Modified Davis classification — 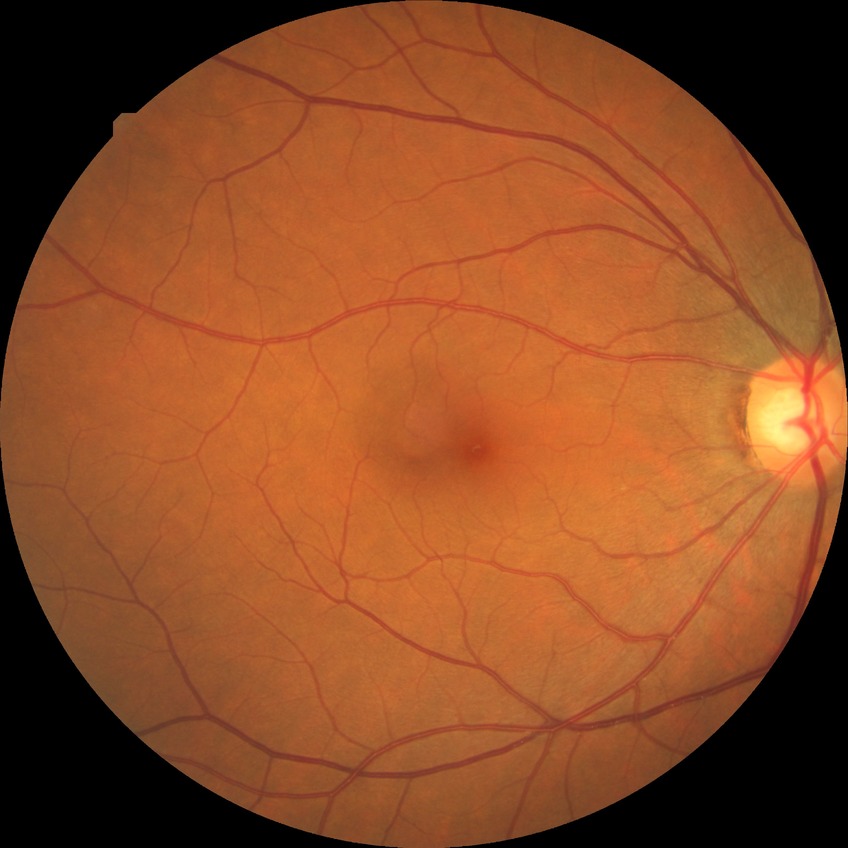
Annotations:
– diabetic retinopathy (DR) — NDR (no diabetic retinopathy)